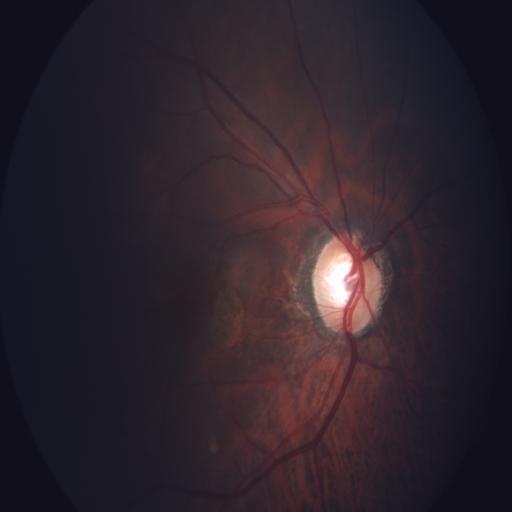

There is evidence of myopia and optic disc cupping.